Acquired with a NIDEK AFC-230. Davis DR grading — 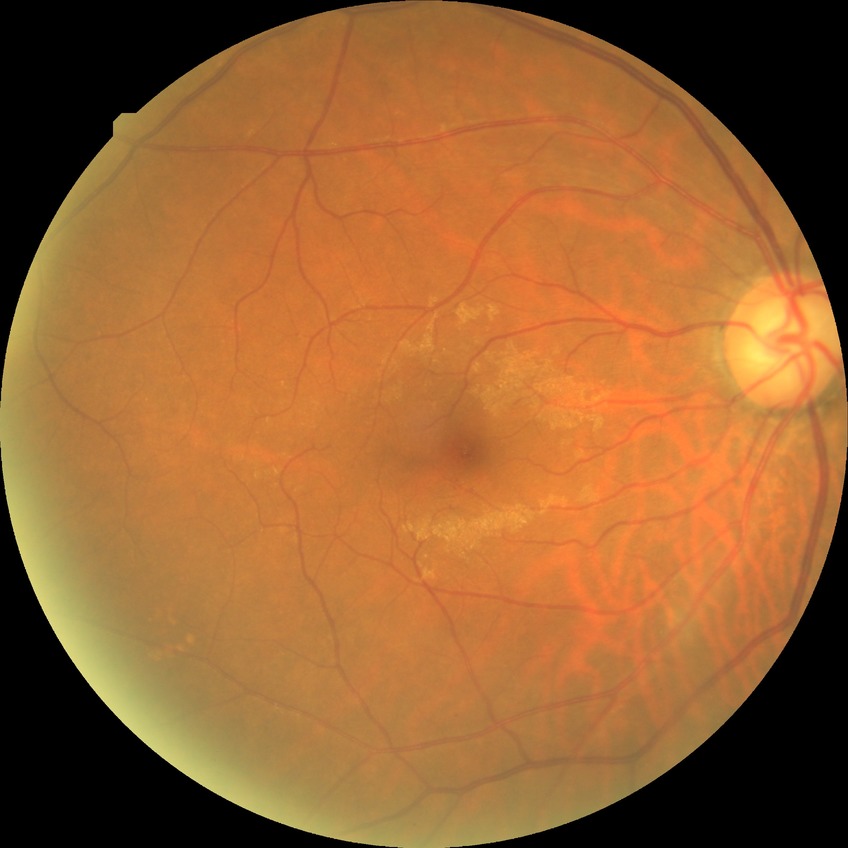
Modified Davis grade is NDR.
No DR findings.